2352 by 1568 pixels. FOV: 45 degrees. Color fundus photograph: 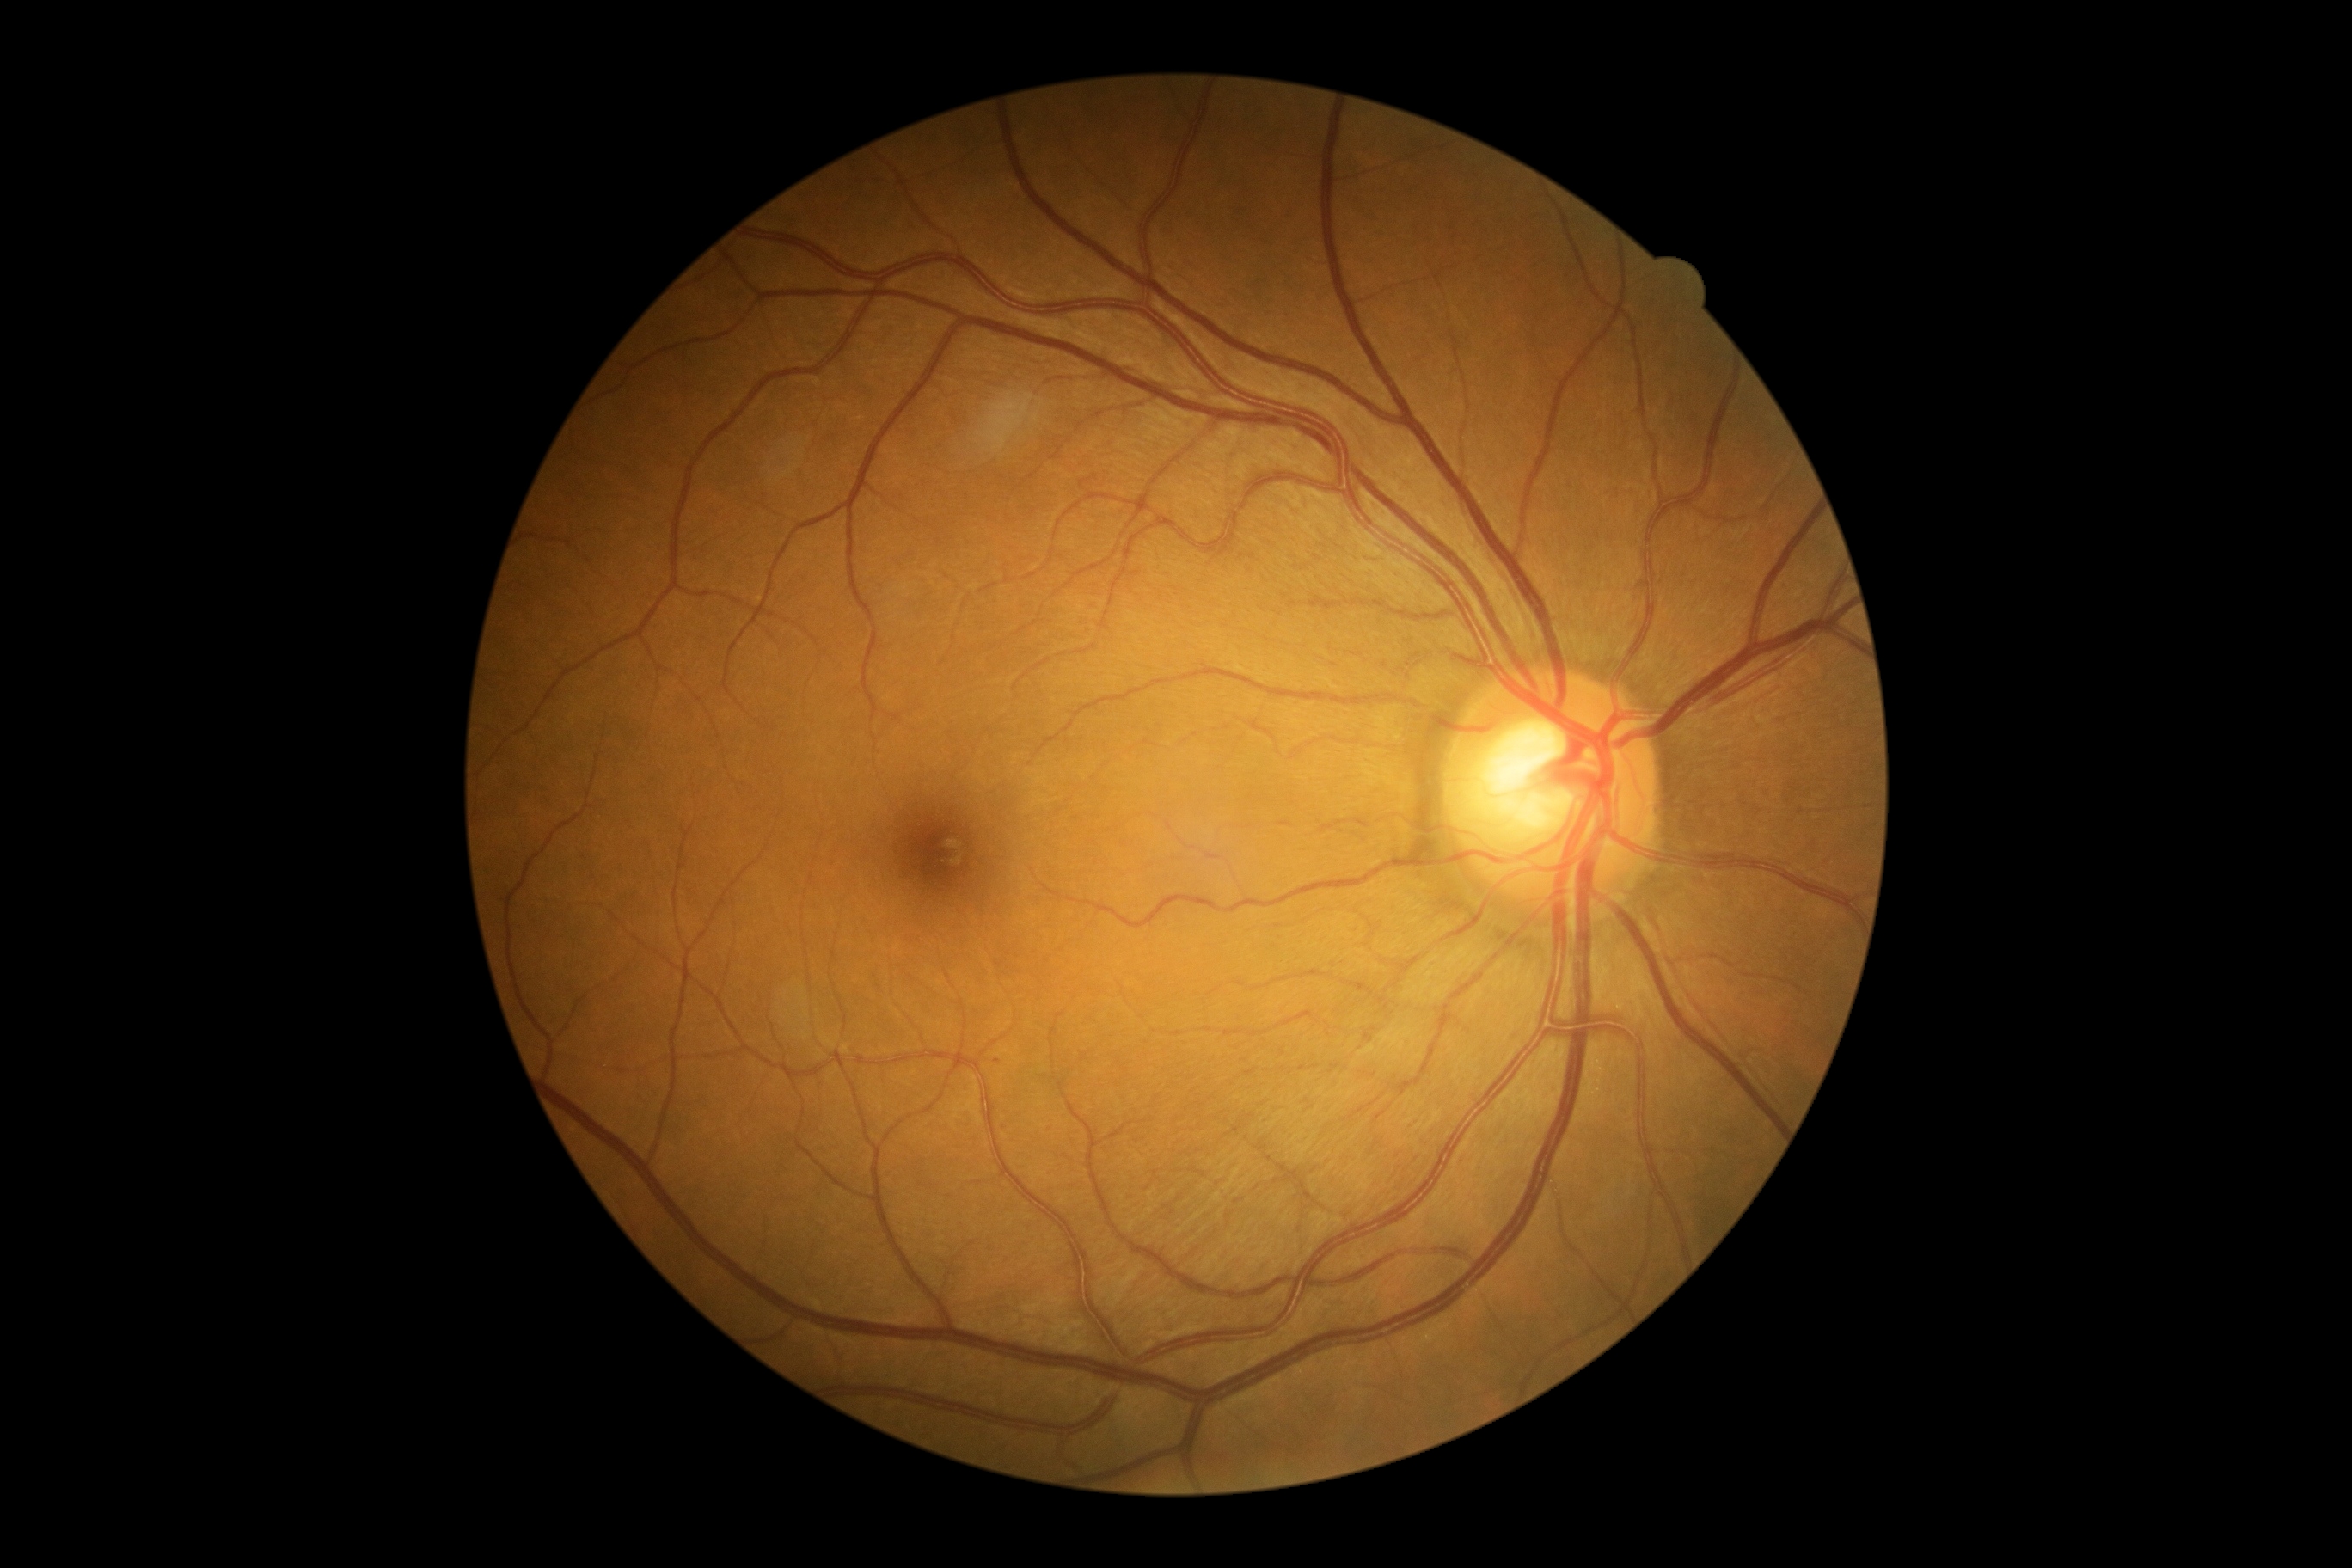
- DR severity: grade 1